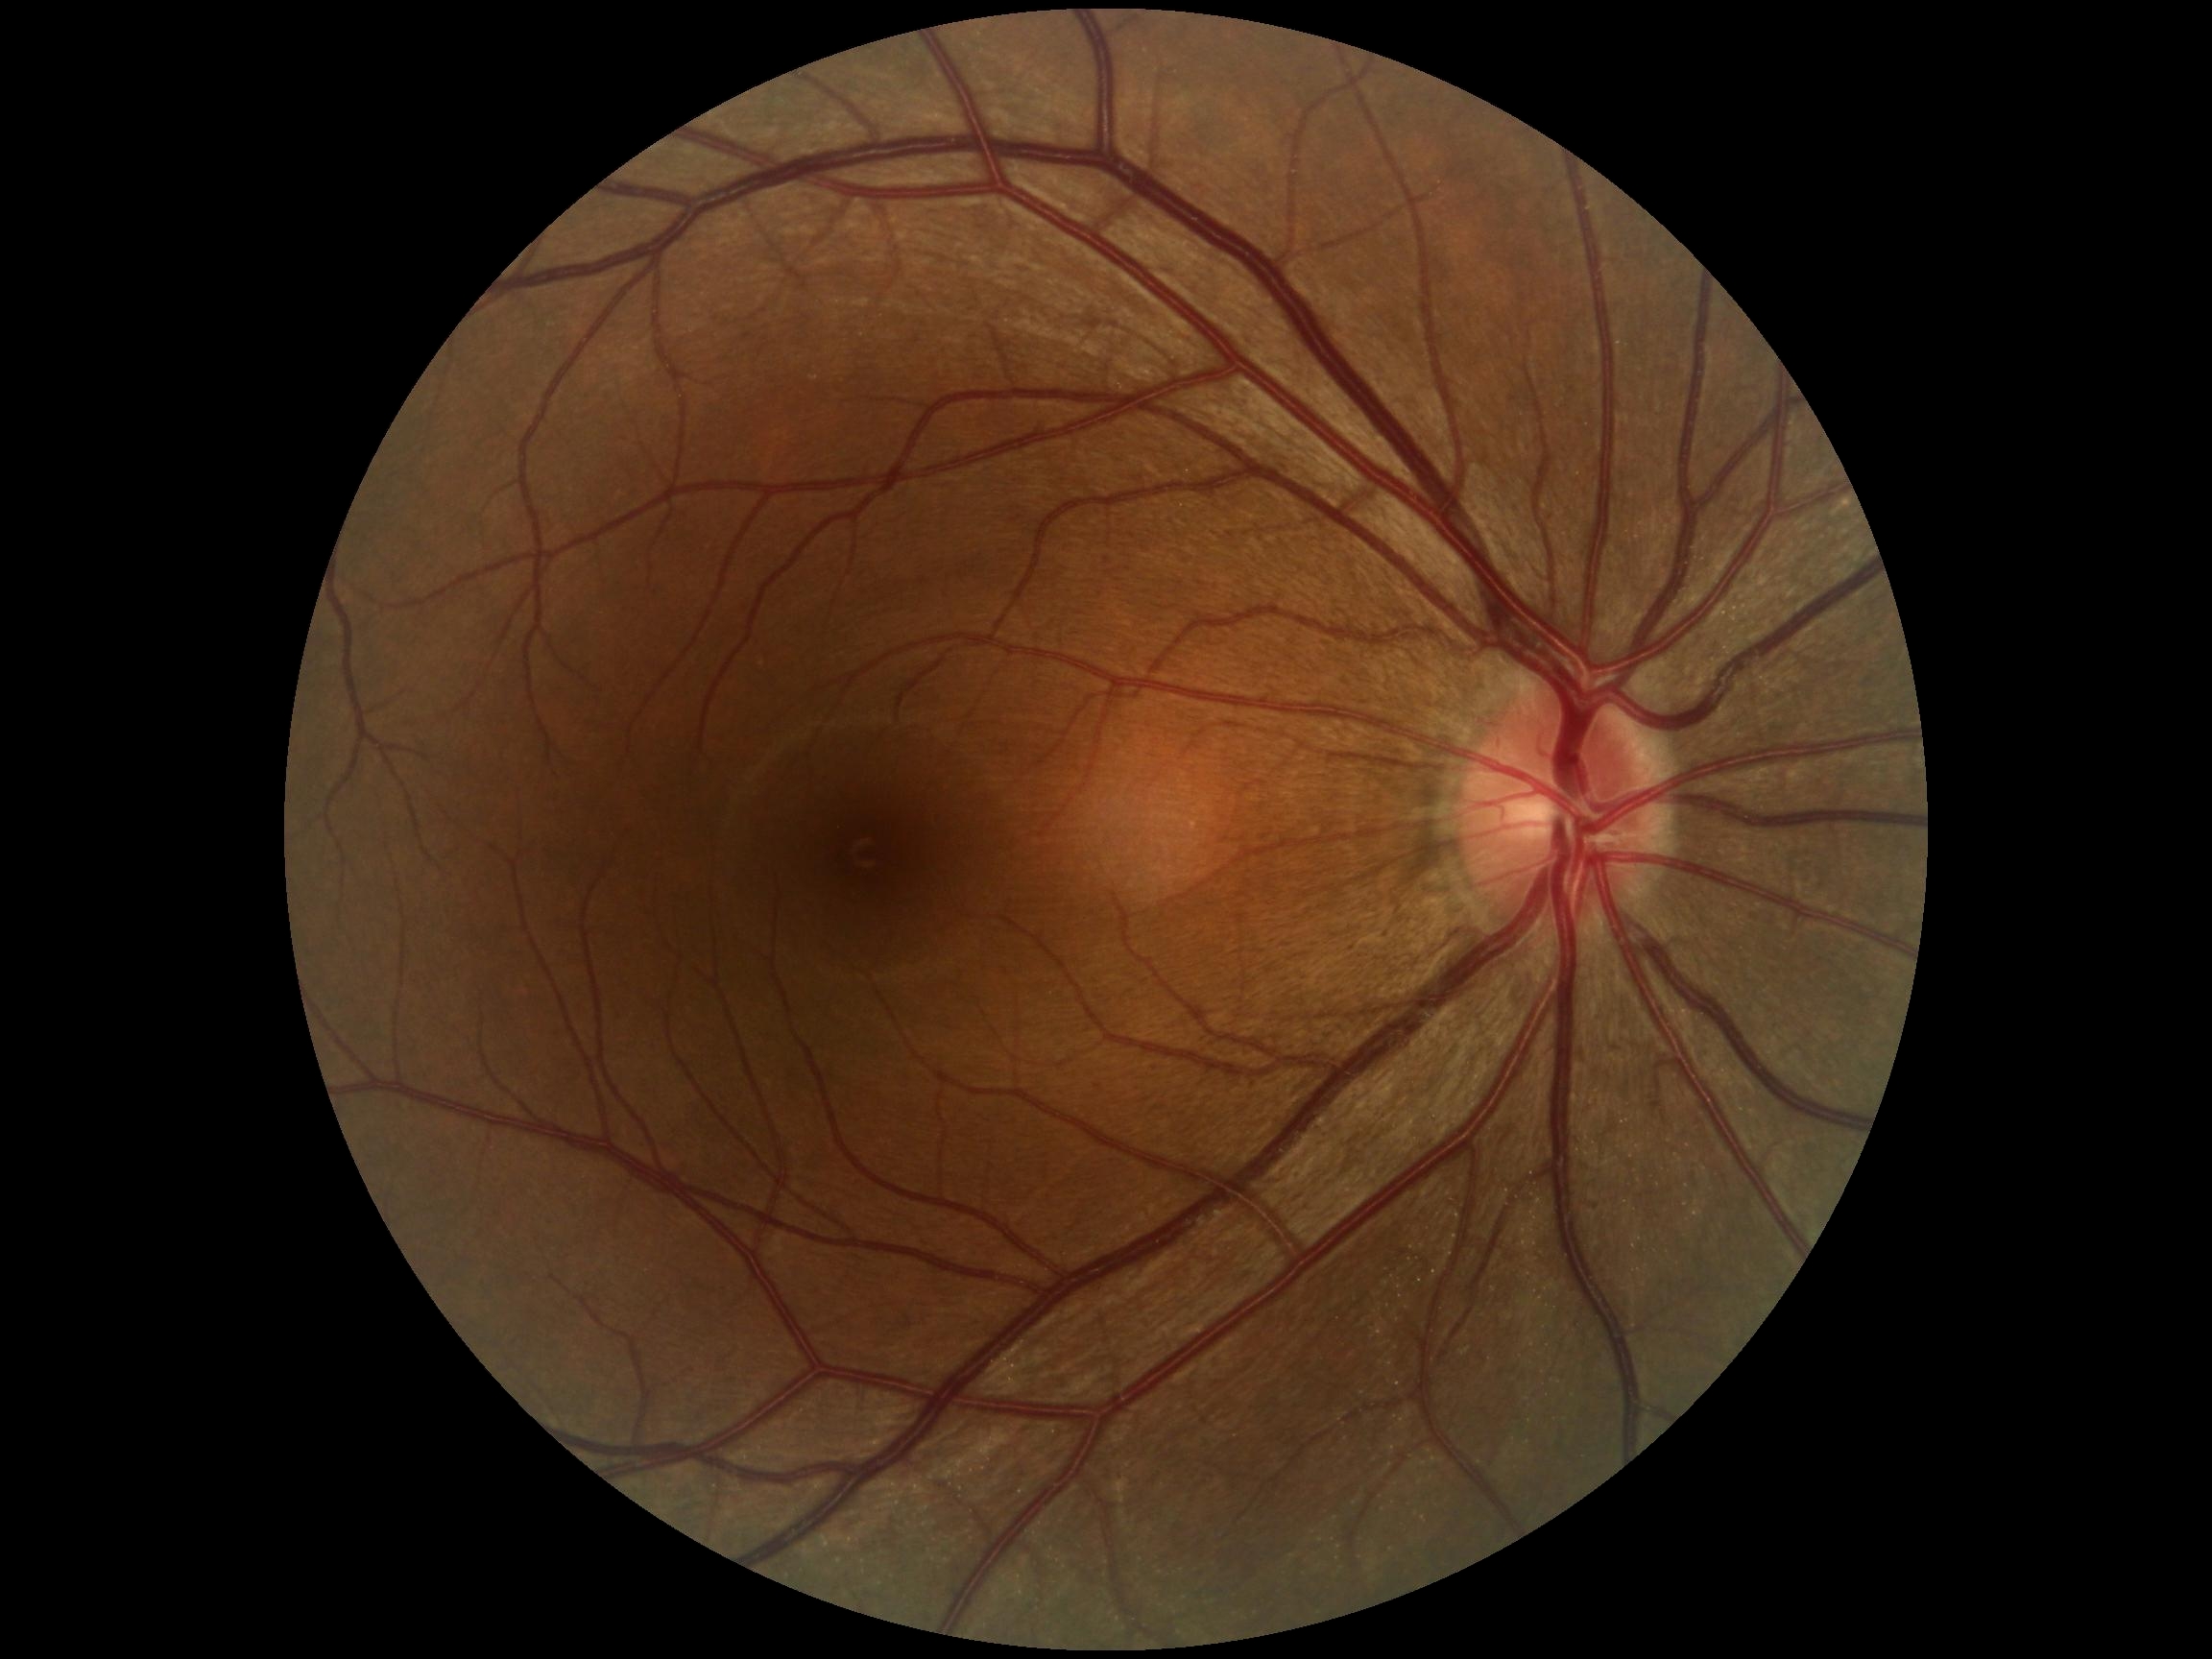

dr_impression: negative for DR
dr_grade: 0